Pediatric retinal photograph (wide-field):
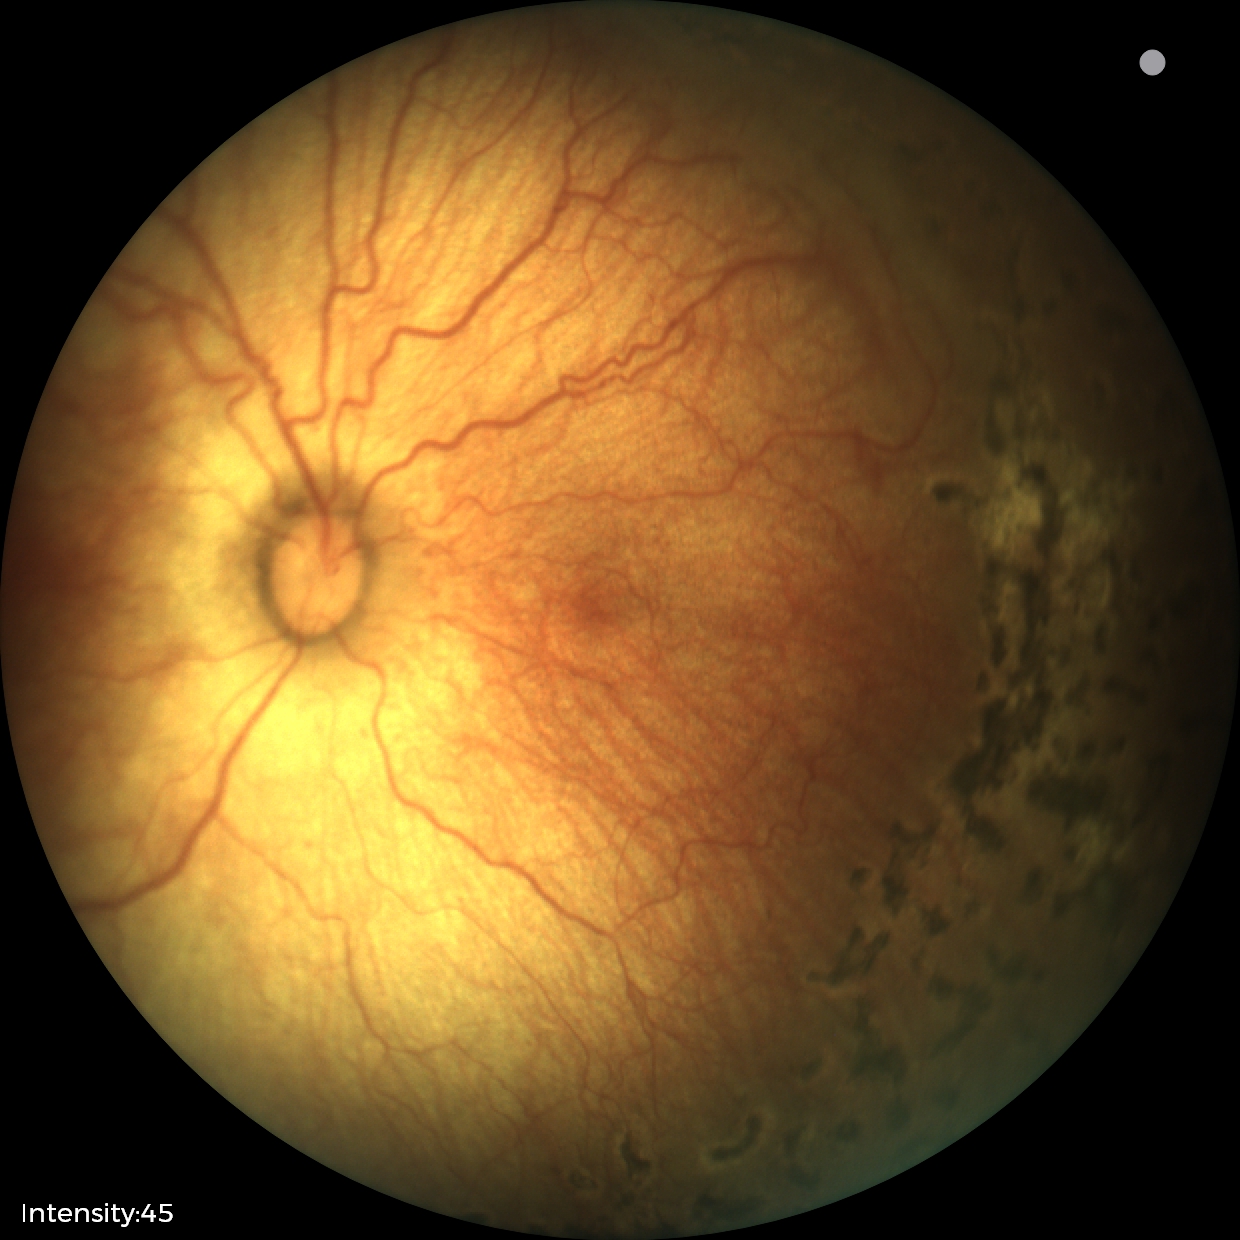 Plus disease = absent — posterior pole vessels without abnormal dilation or tortuosity; finding = status post retinopathy of prematurity.